Wide-field fundus photograph of an infant — 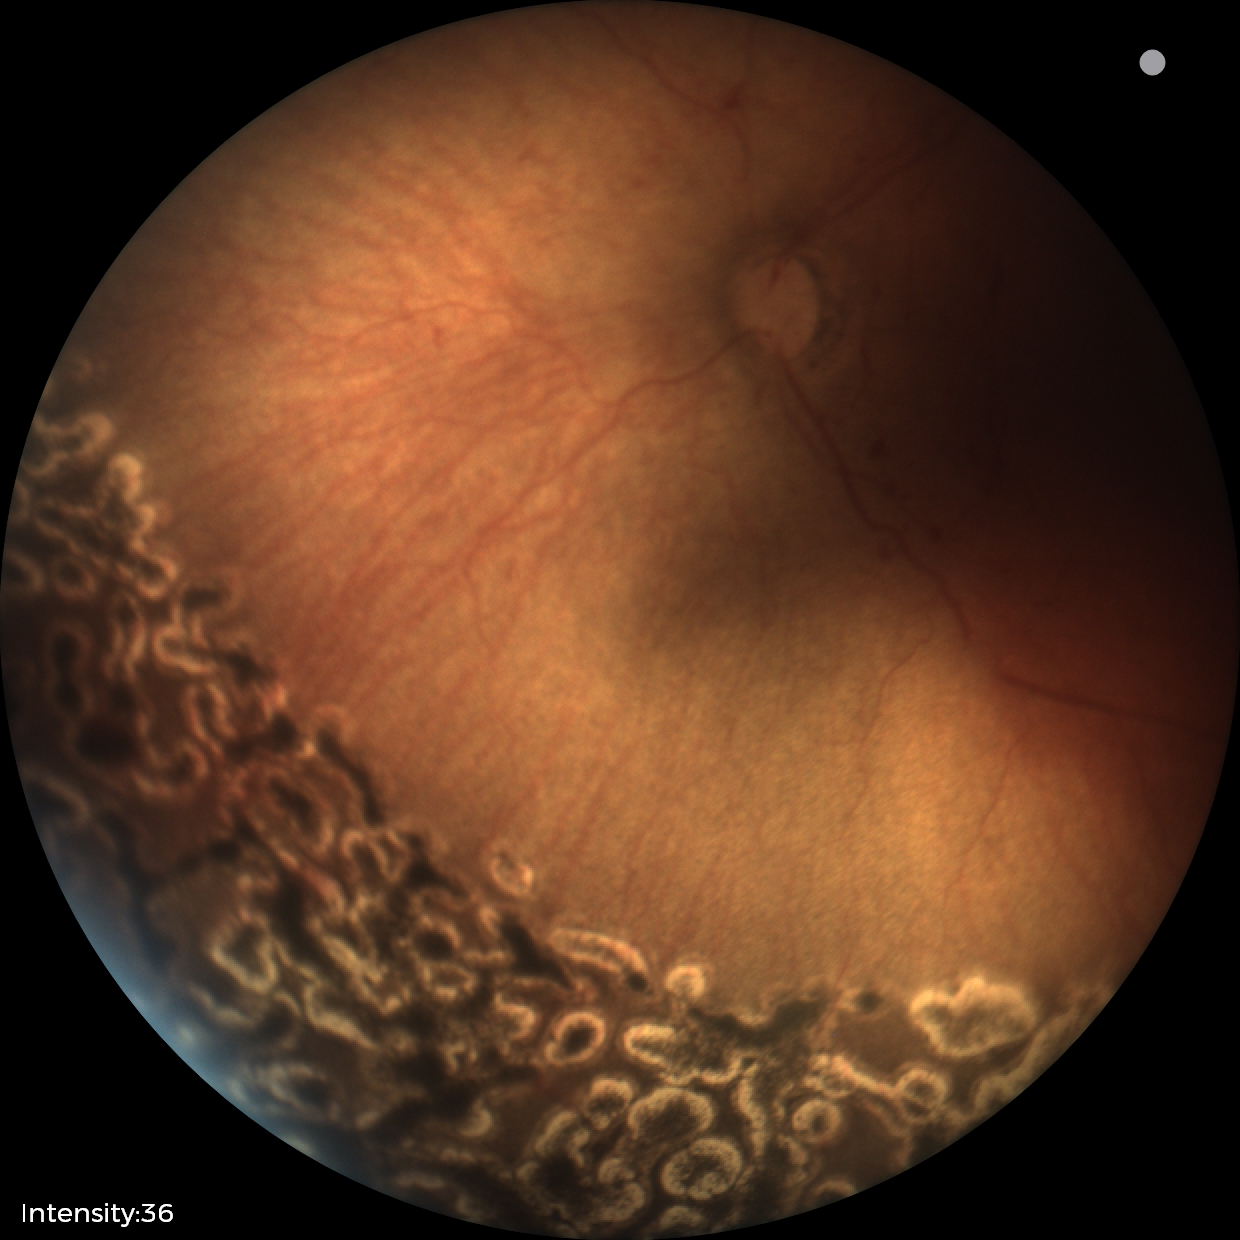 Assessment: no plus disease | status post retinopathy of prematurity.